2048 by 1536 pixels · 45-degree field of view: 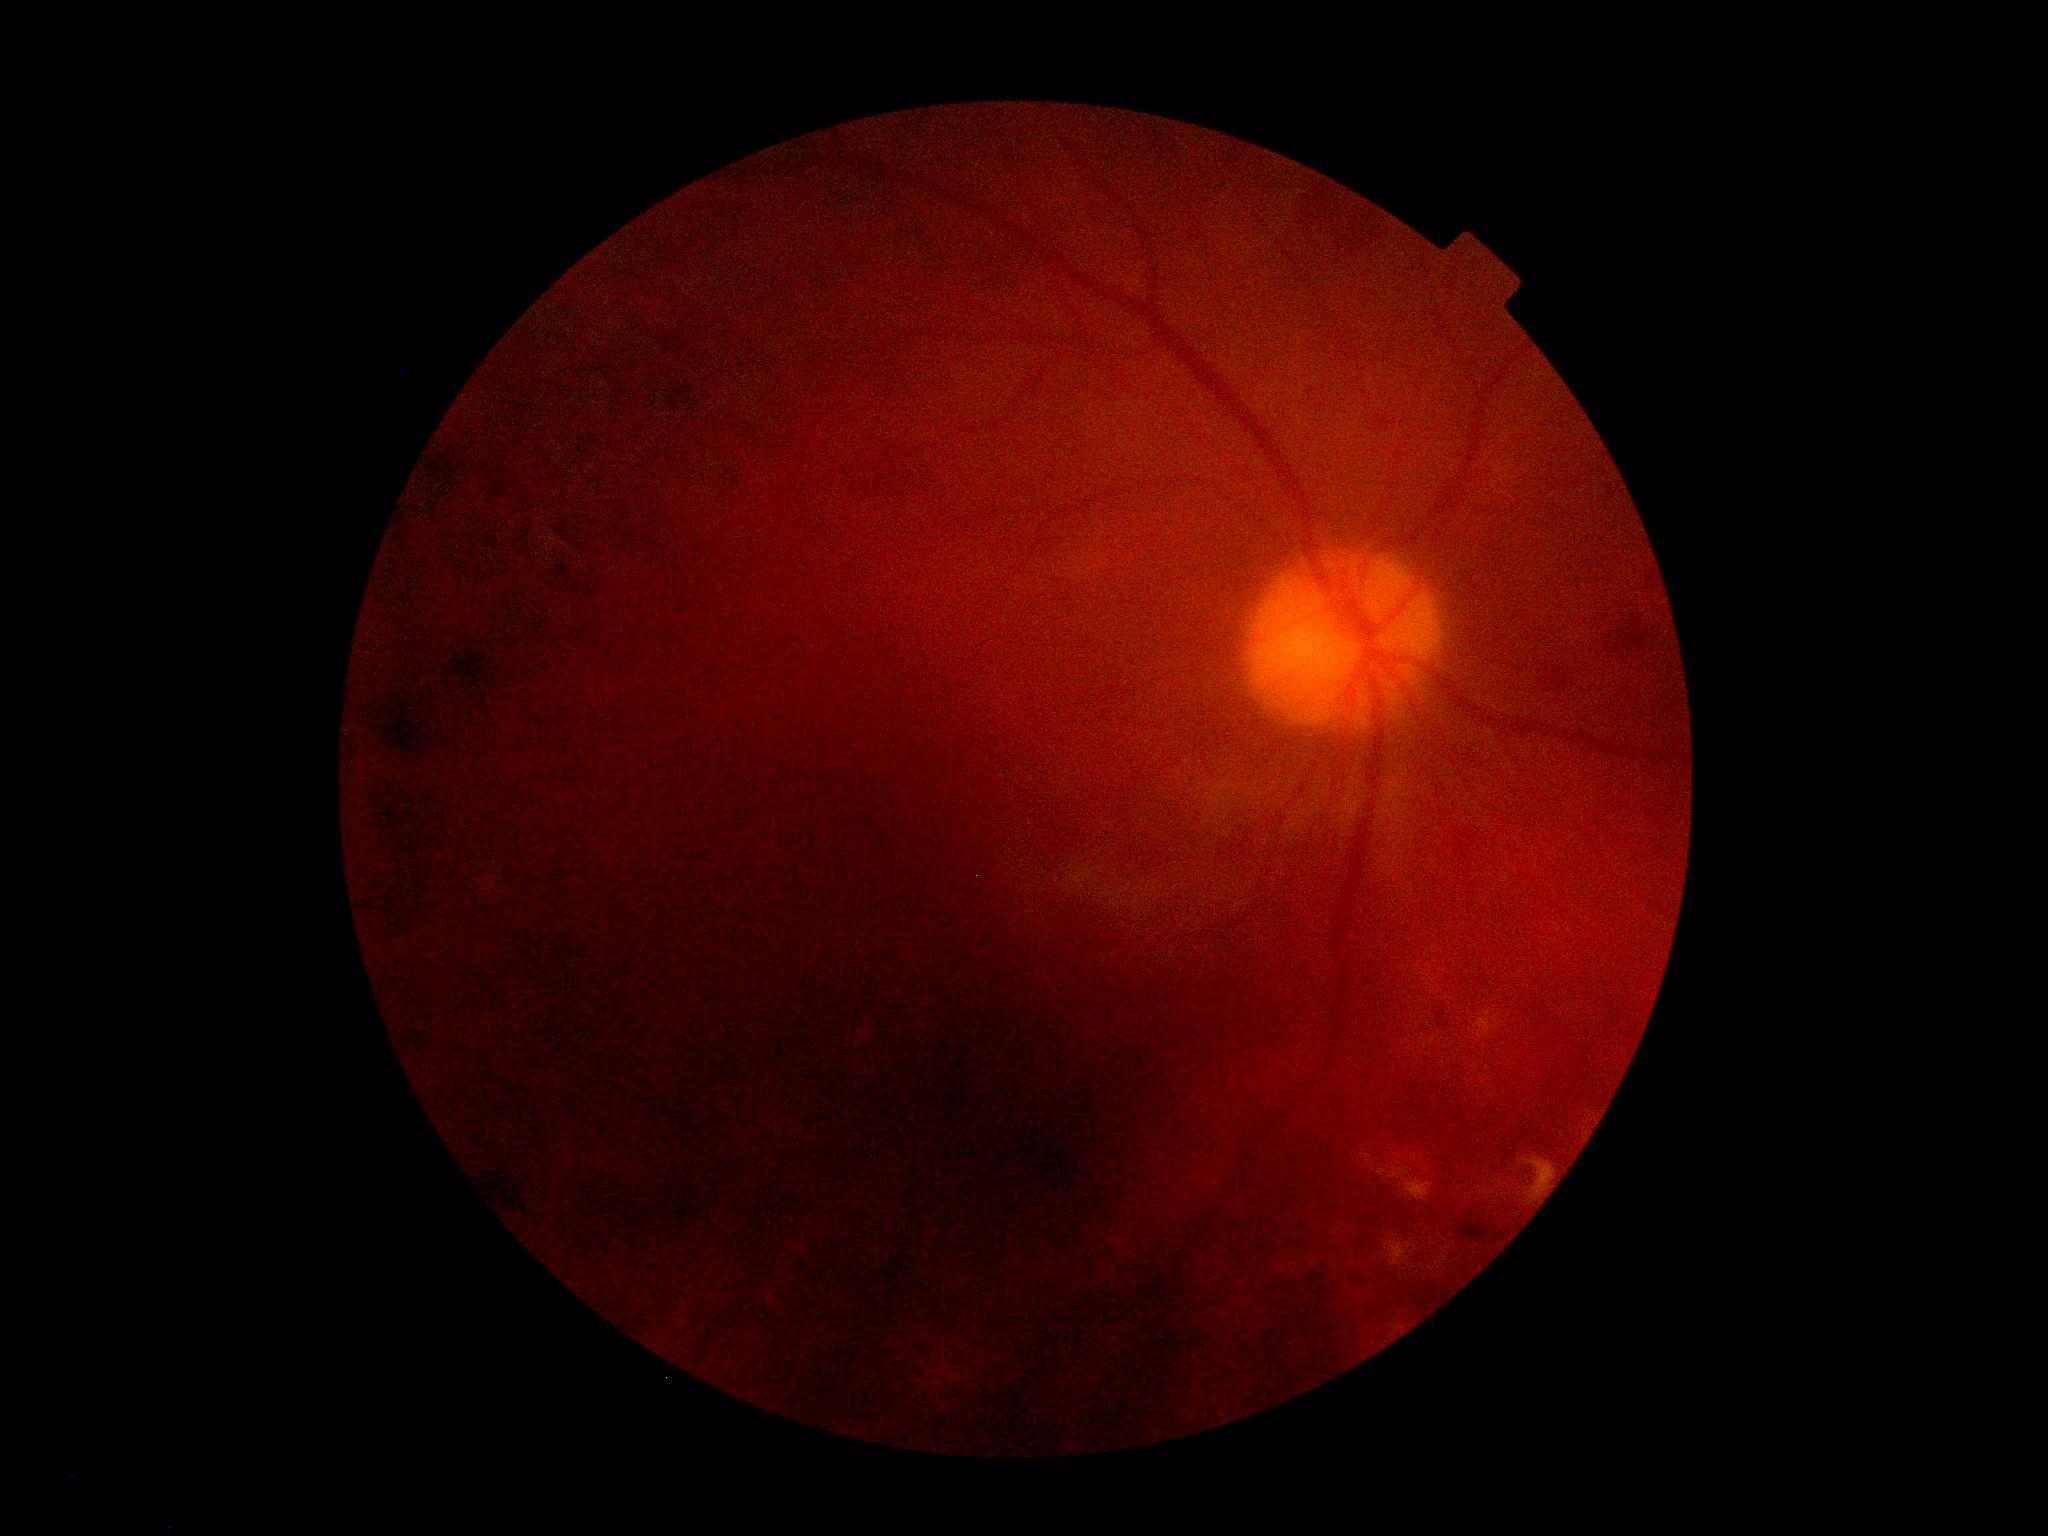 diabetic retinopathy = ungradable due to poor image quality | image quality = below grading threshold.